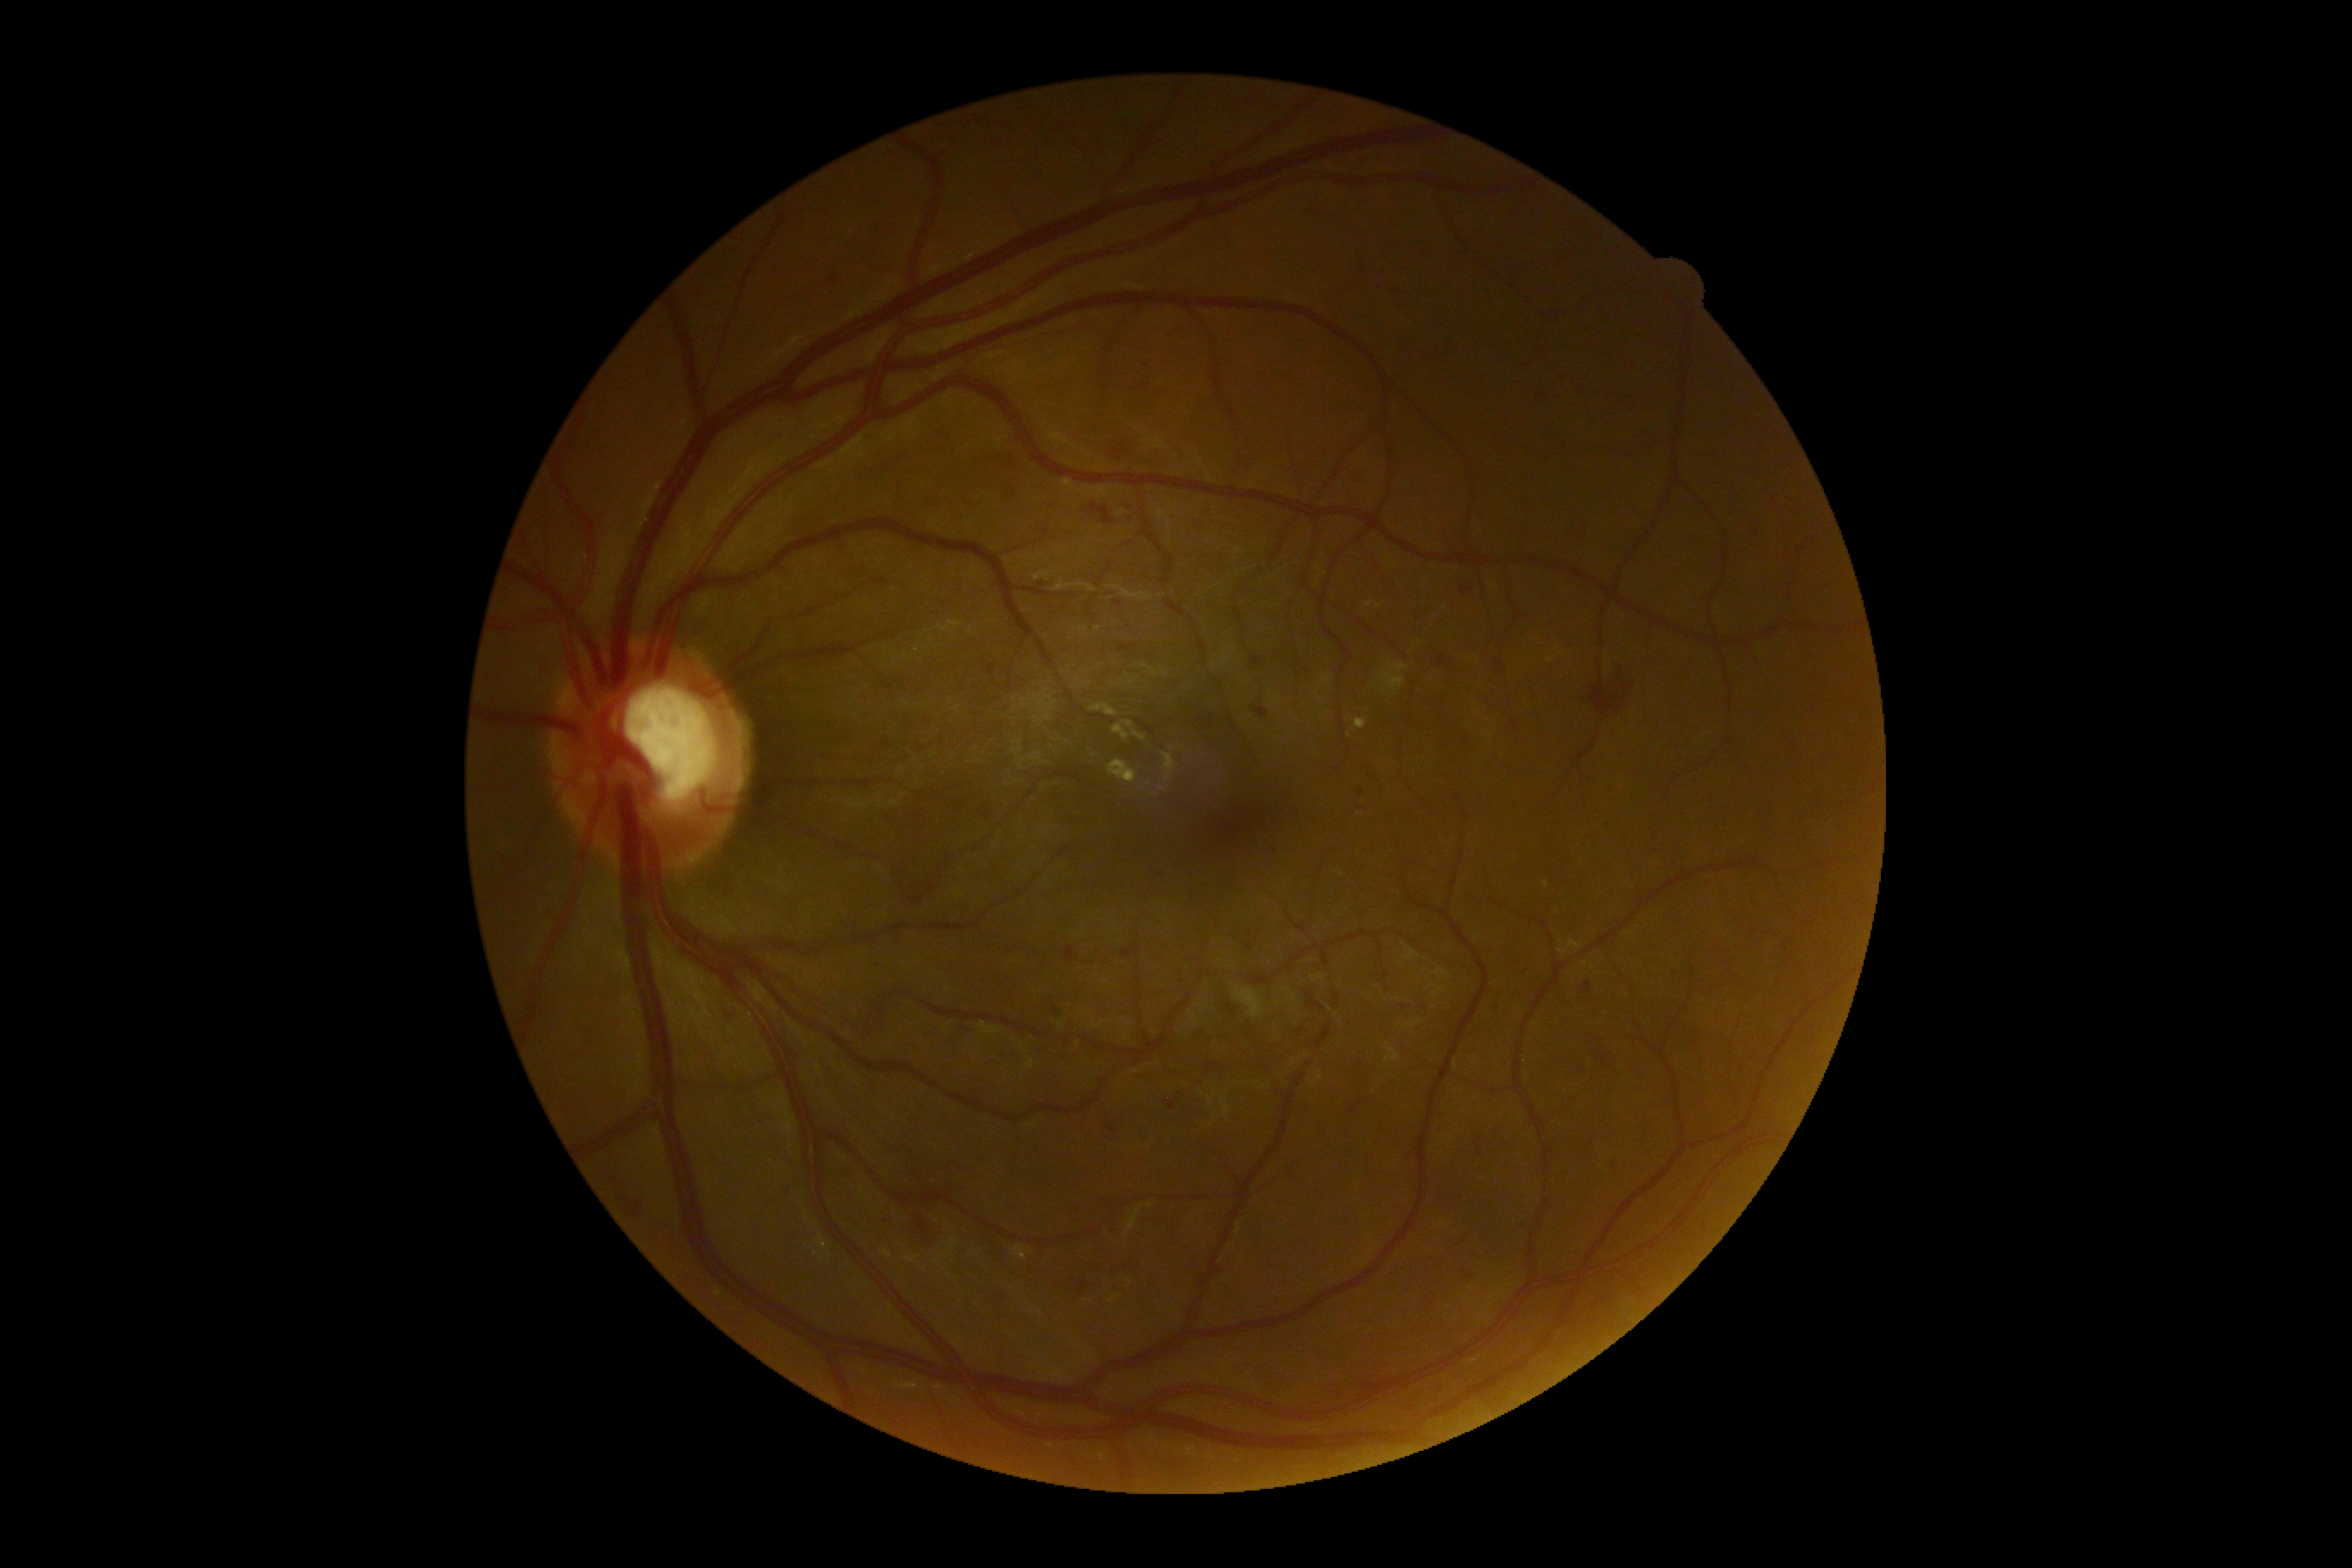 Retinopathy: 2
Representative lesions:
hemorrhages (subset) = [left=1246, top=943, right=1253, bottom=952], [left=1118, top=646, right=1137, bottom=651], [left=1512, top=720, right=1521, bottom=733], [left=1457, top=1266, right=1476, bottom=1285], [left=627, top=1196, right=647, bottom=1218], [left=1253, top=658, right=1263, bottom=671], [left=1579, top=981, right=1595, bottom=1000], [left=1526, top=683, right=1538, bottom=701], [left=1746, top=527, right=1763, bottom=542], [left=1493, top=659, right=1505, bottom=675], [left=1488, top=1000, right=1505, bottom=1014], [left=905, top=1213, right=941, bottom=1246]
Additional small hemorrhages near [x=1544, y=398], [x=1057, y=1011], [x=1129, y=508]